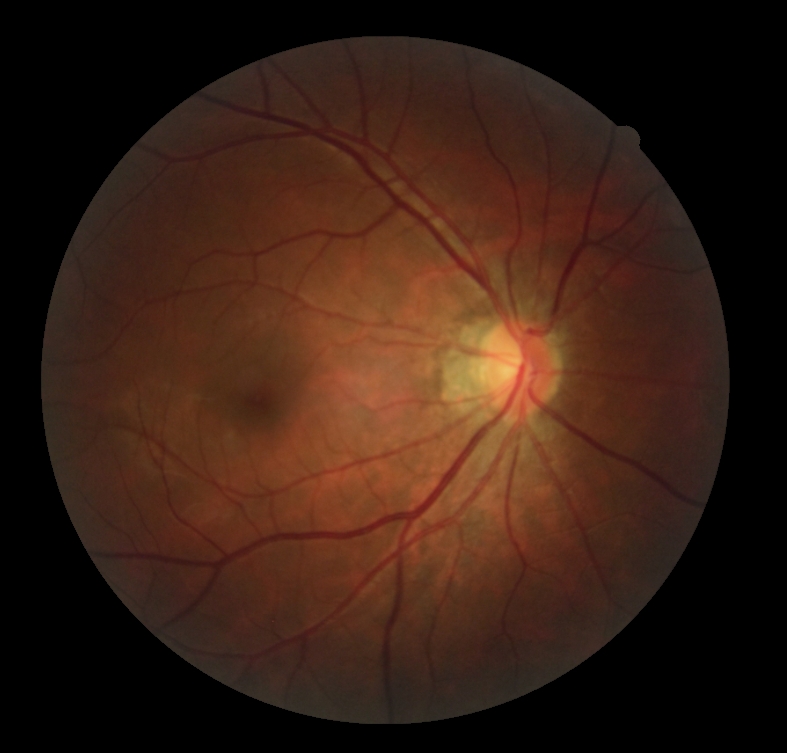 diabetic retinopathy severity = 0/4.